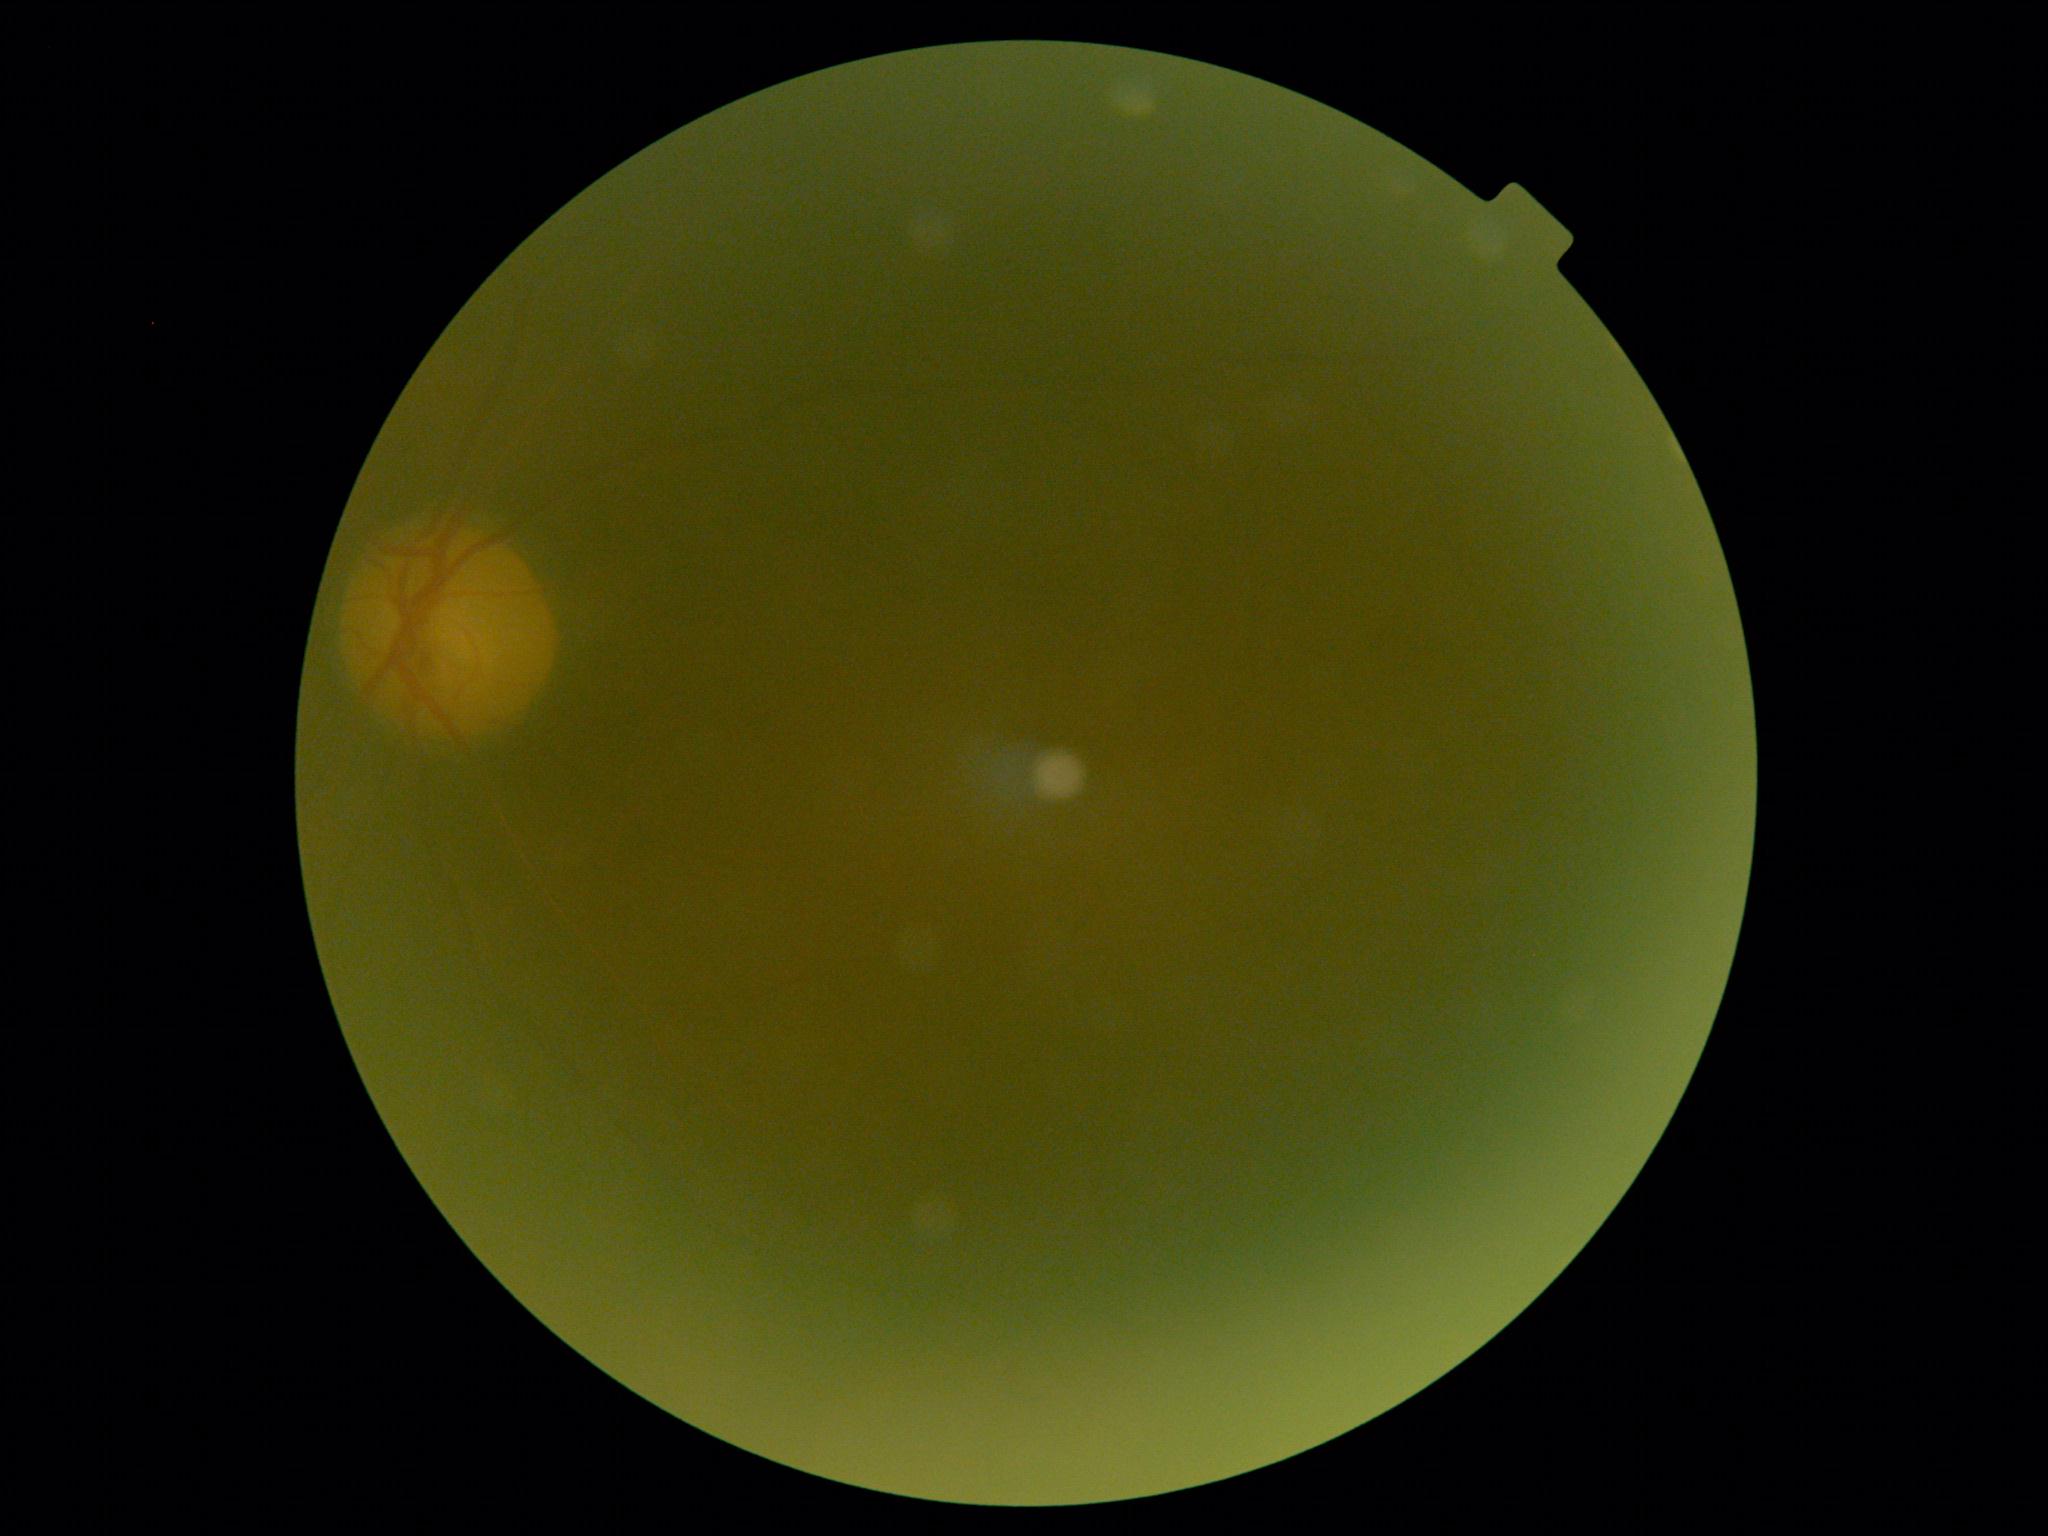

Image quality is insufficient for diabetic retinopathy assessment.
DR stage is ungradable due to poor image quality.